NIDEK AFC-230 fundus camera. Diabetic retinopathy graded by the modified Davis classification — 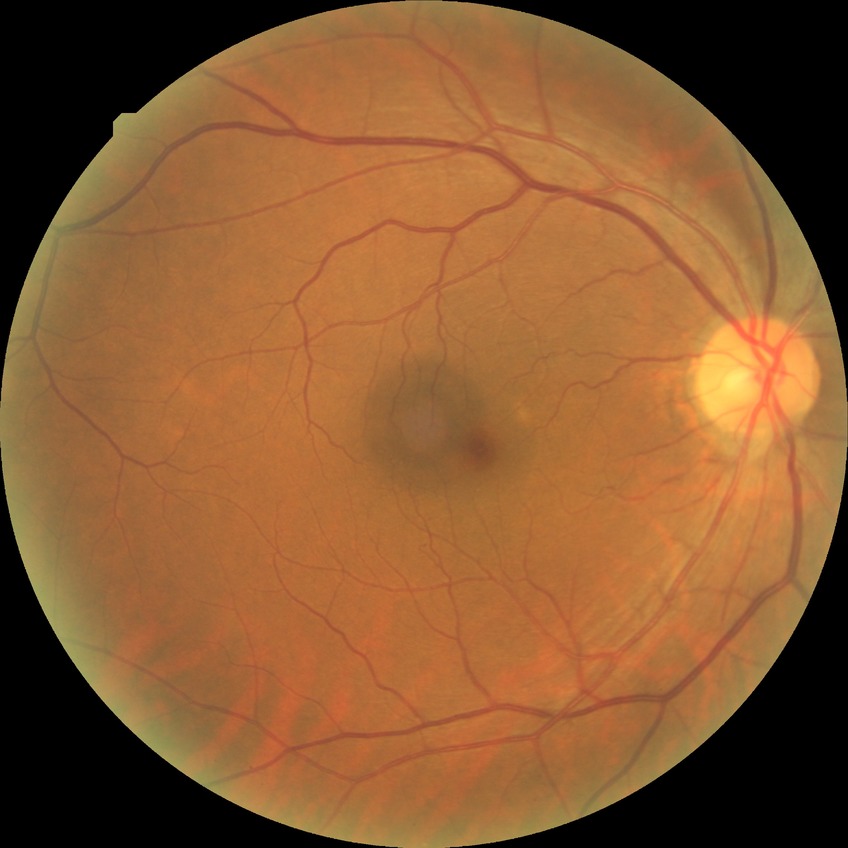 DR grade is NDR.